45-degree field of view · posterior pole color fundus photograph.
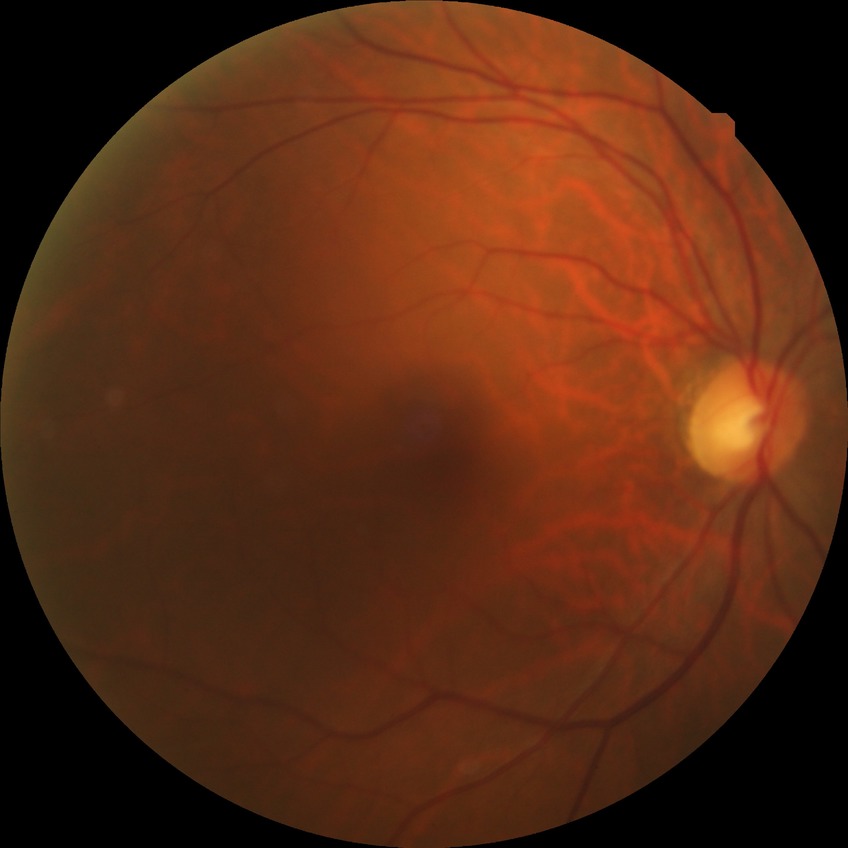 Retinopathy grade is no diabetic retinopathy.